50-degree field of view, color fundus image — 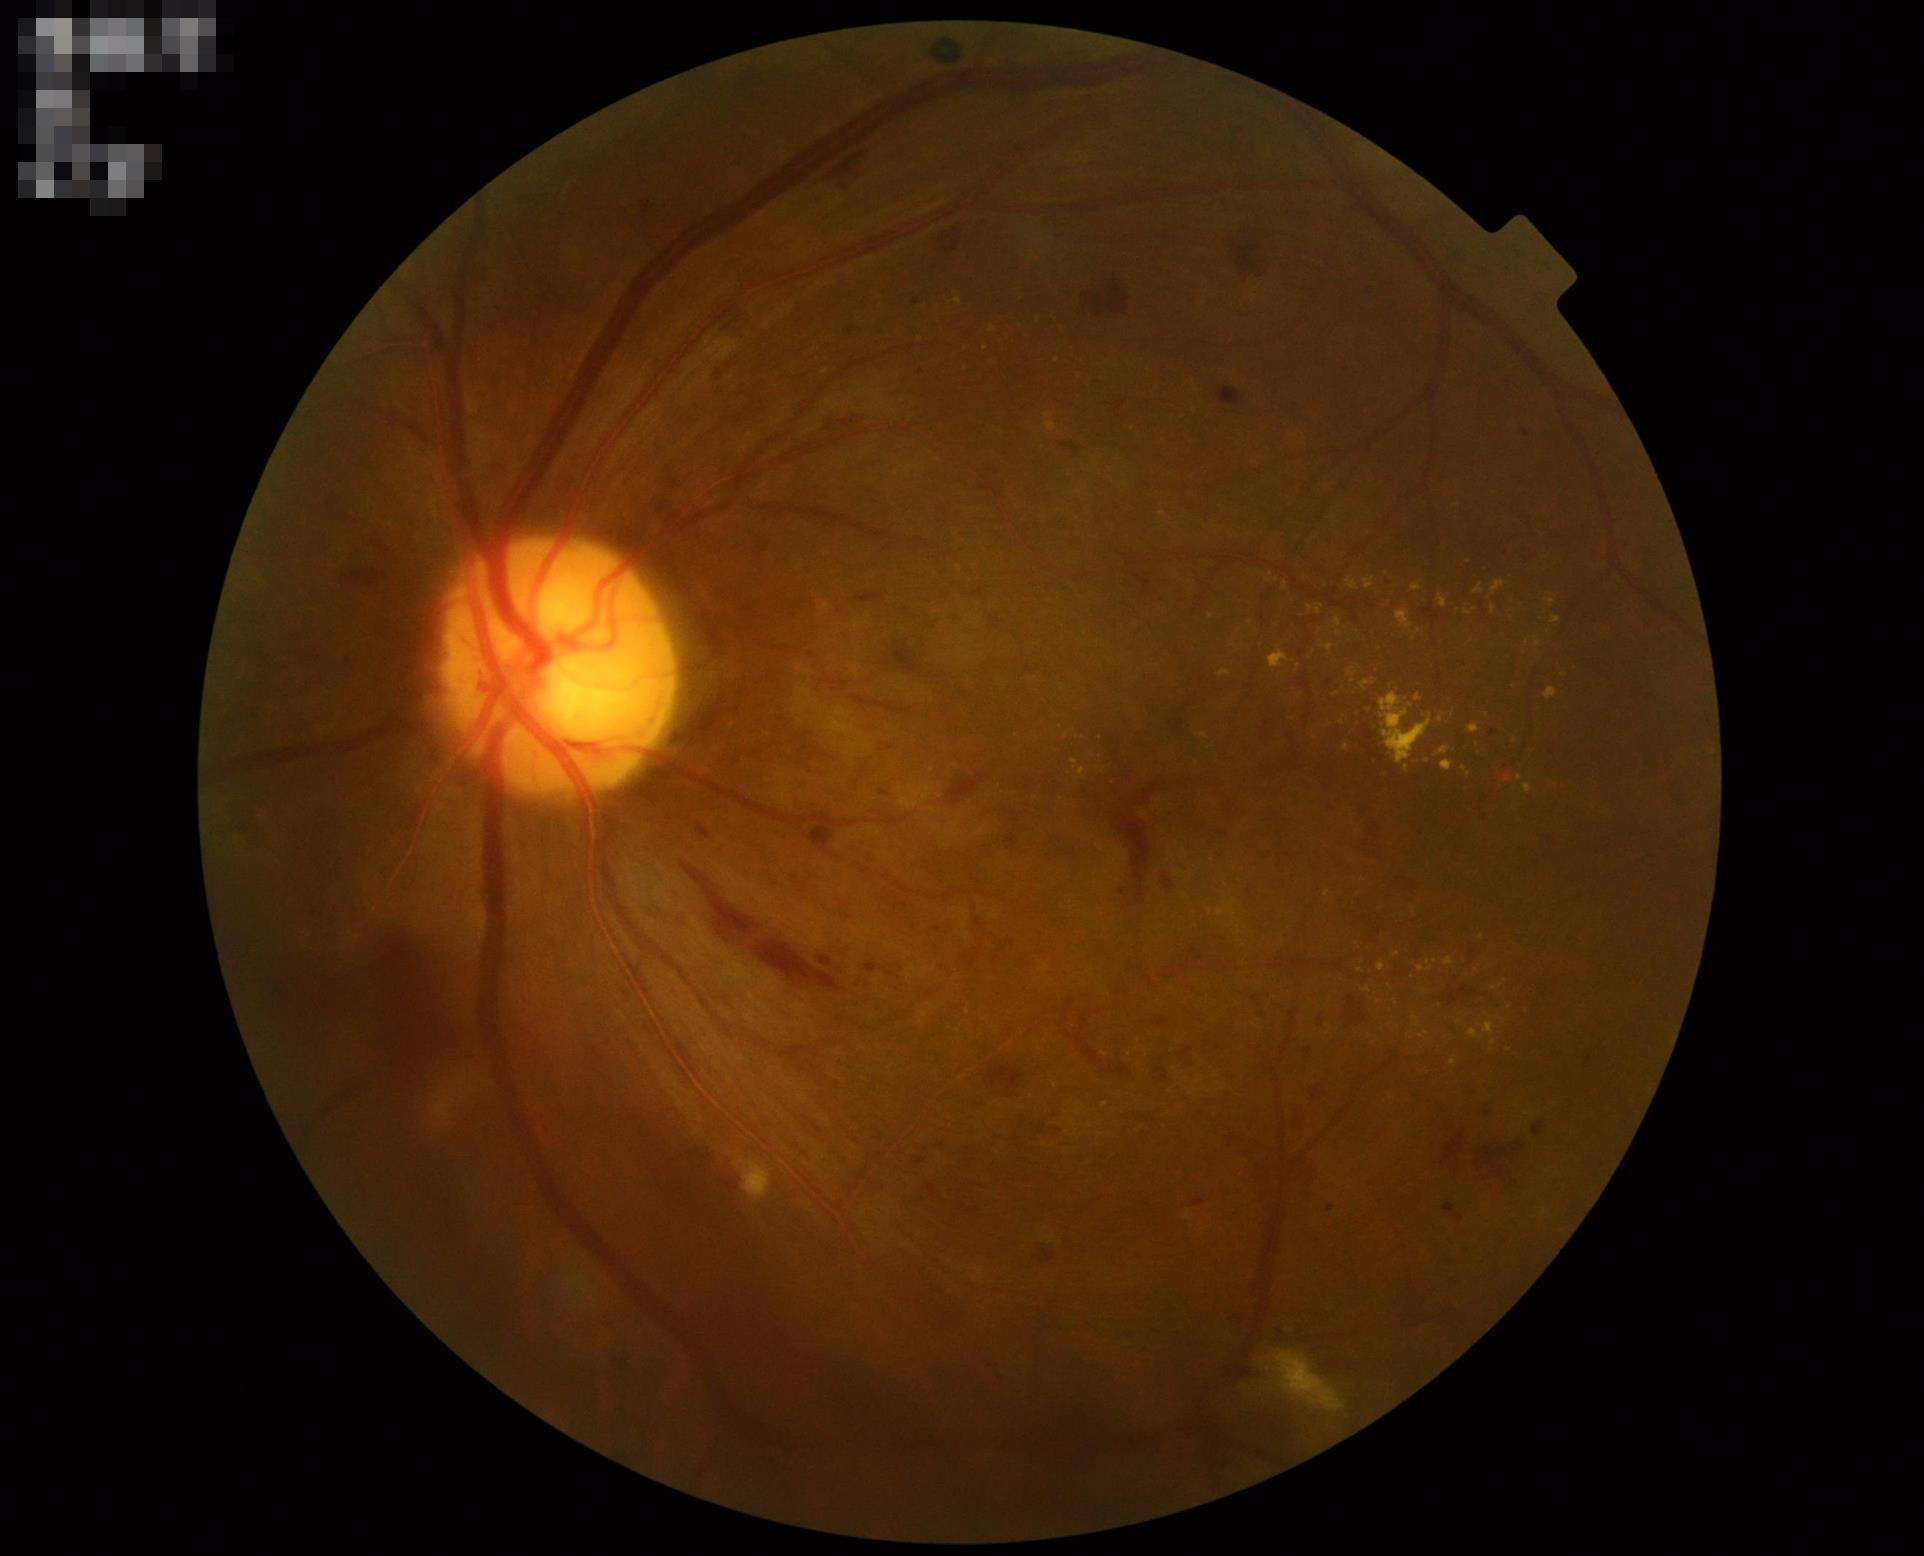
Illumination is even. Overall image quality is good. Contrast is good.